Wide-field contact fundus photograph of an infant — 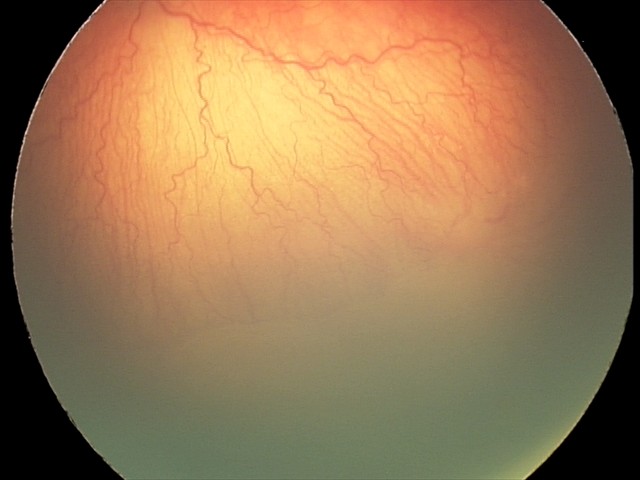
Diagnosis = aggressive retinopathy of prematurity (A-ROP) | plus form = present — abnormal dilation and tortuosity of the posterior pole retinal vessels.